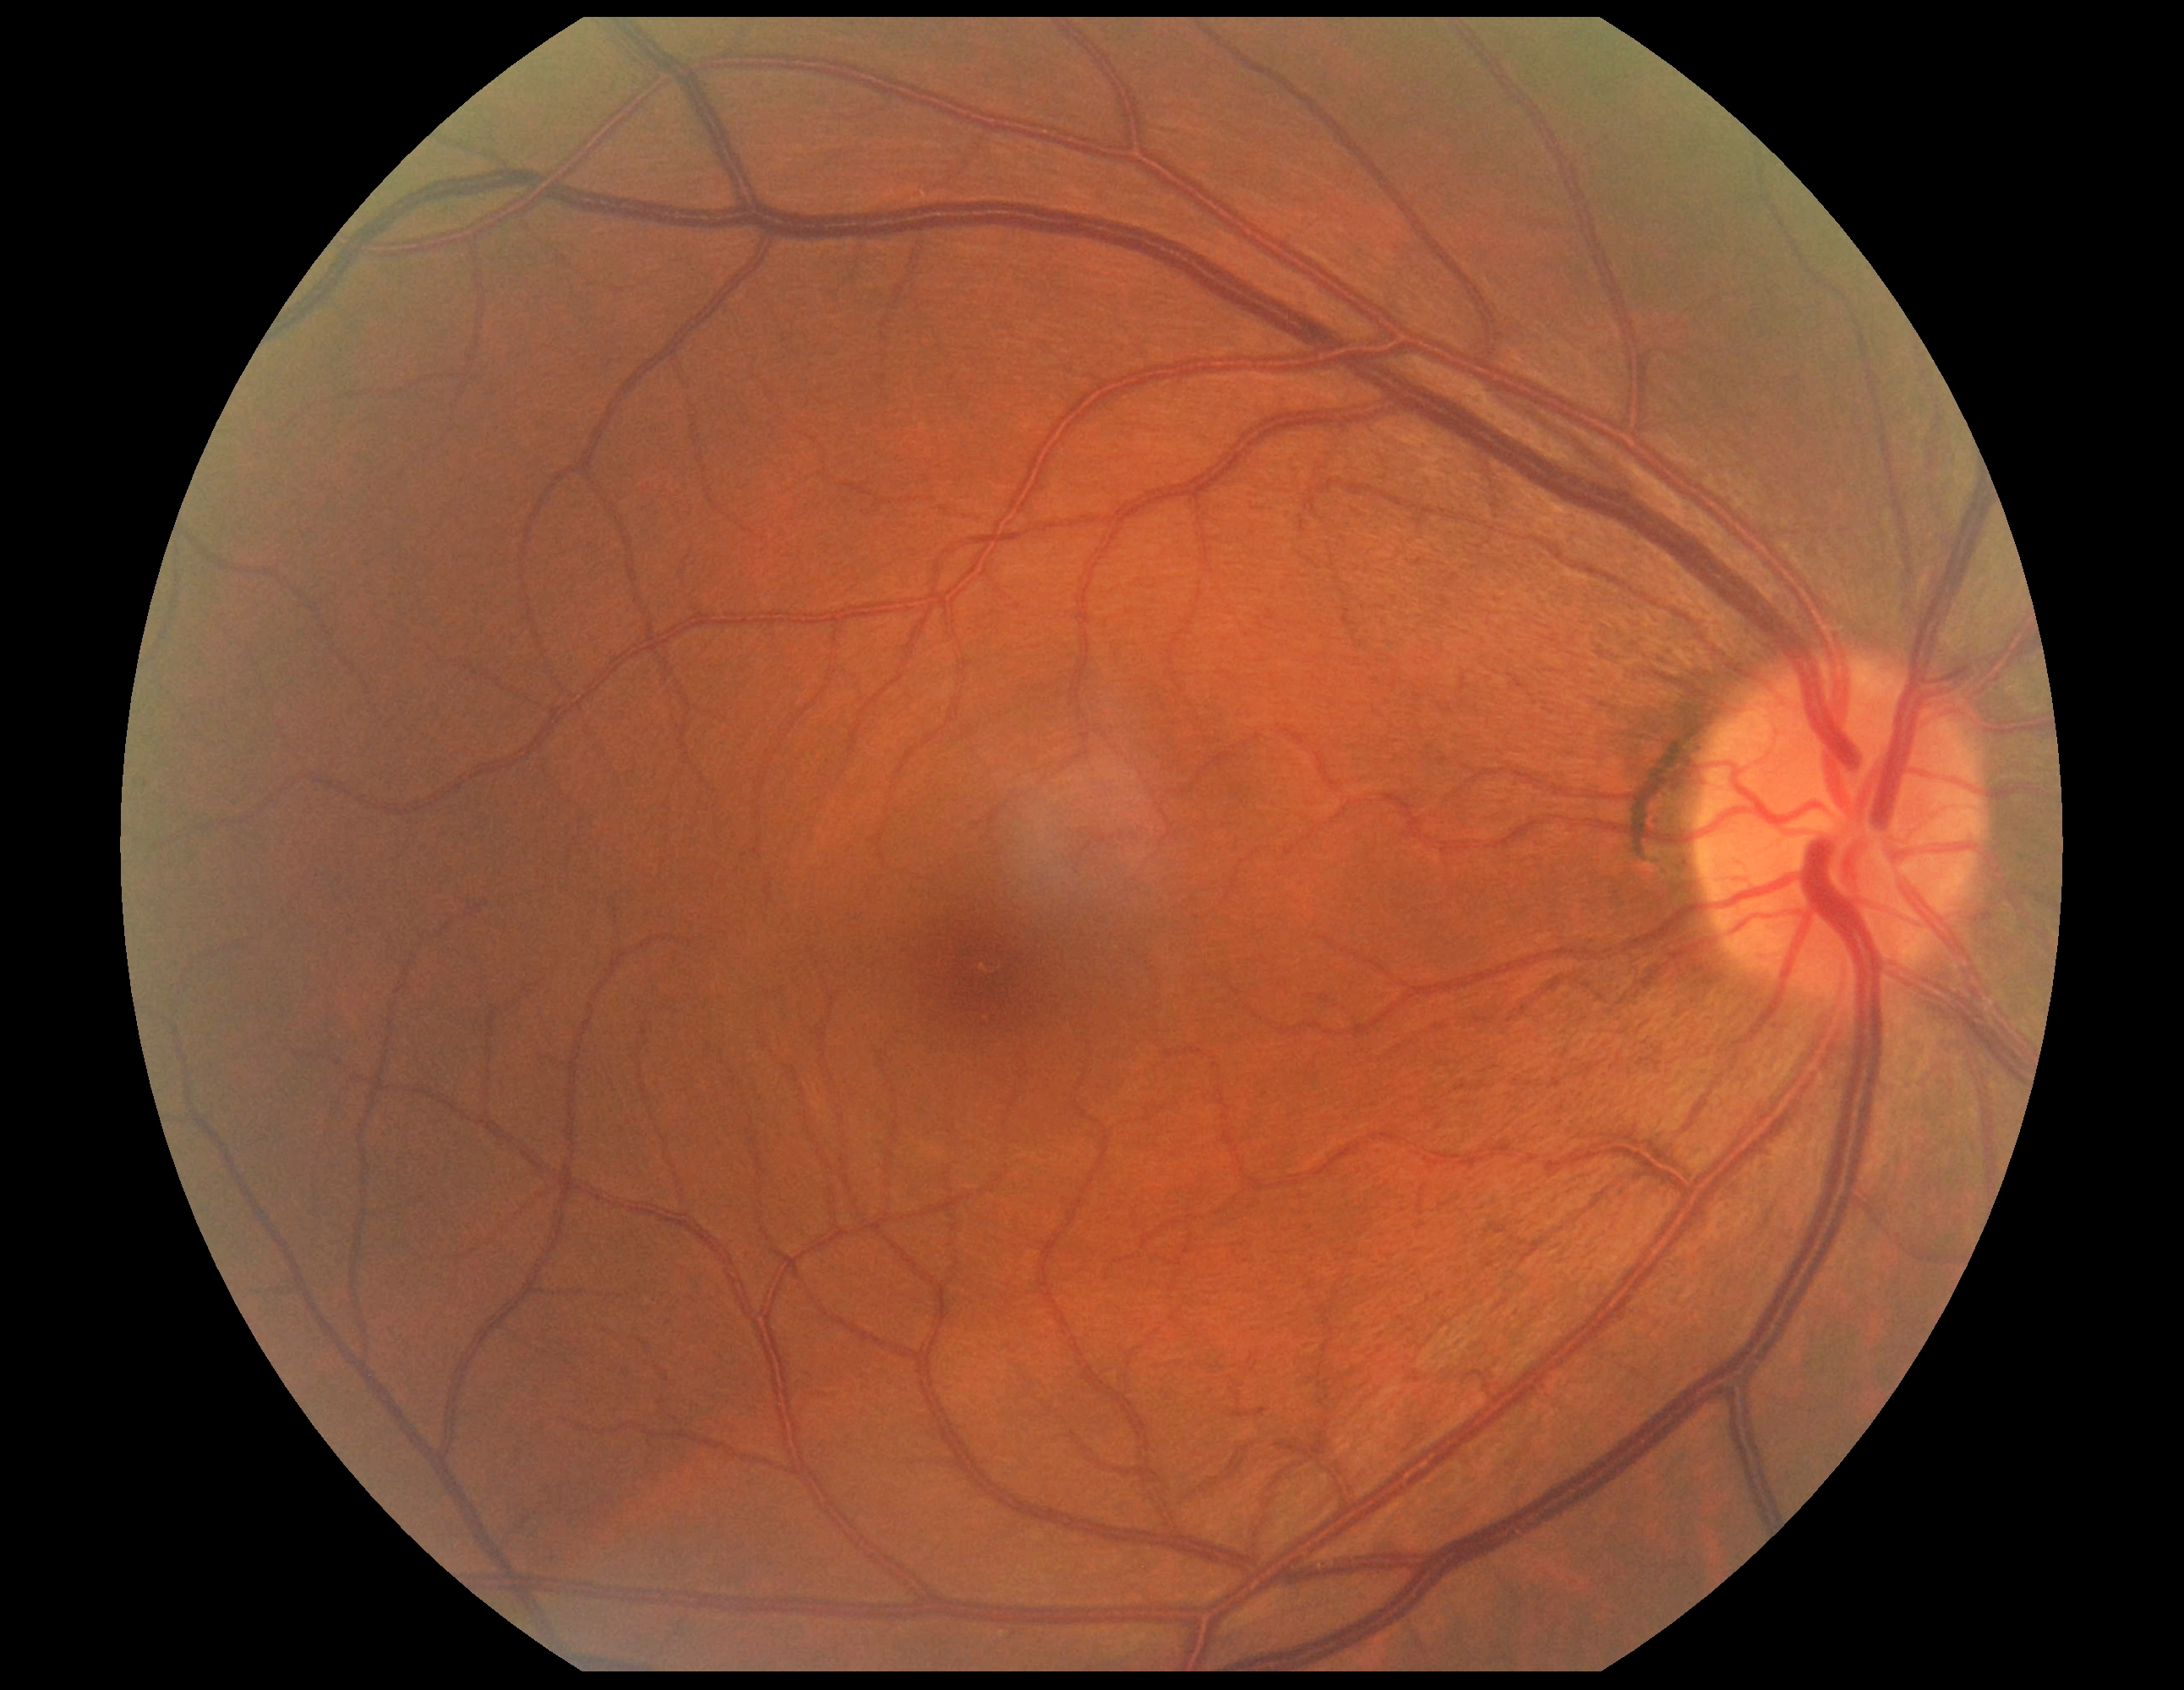 Diabetic retinopathy grade is 0/4.